Acquired on the Phoenix ICON. 1240 x 1240 pixels. Wide-field fundus photograph from neonatal ROP screening.
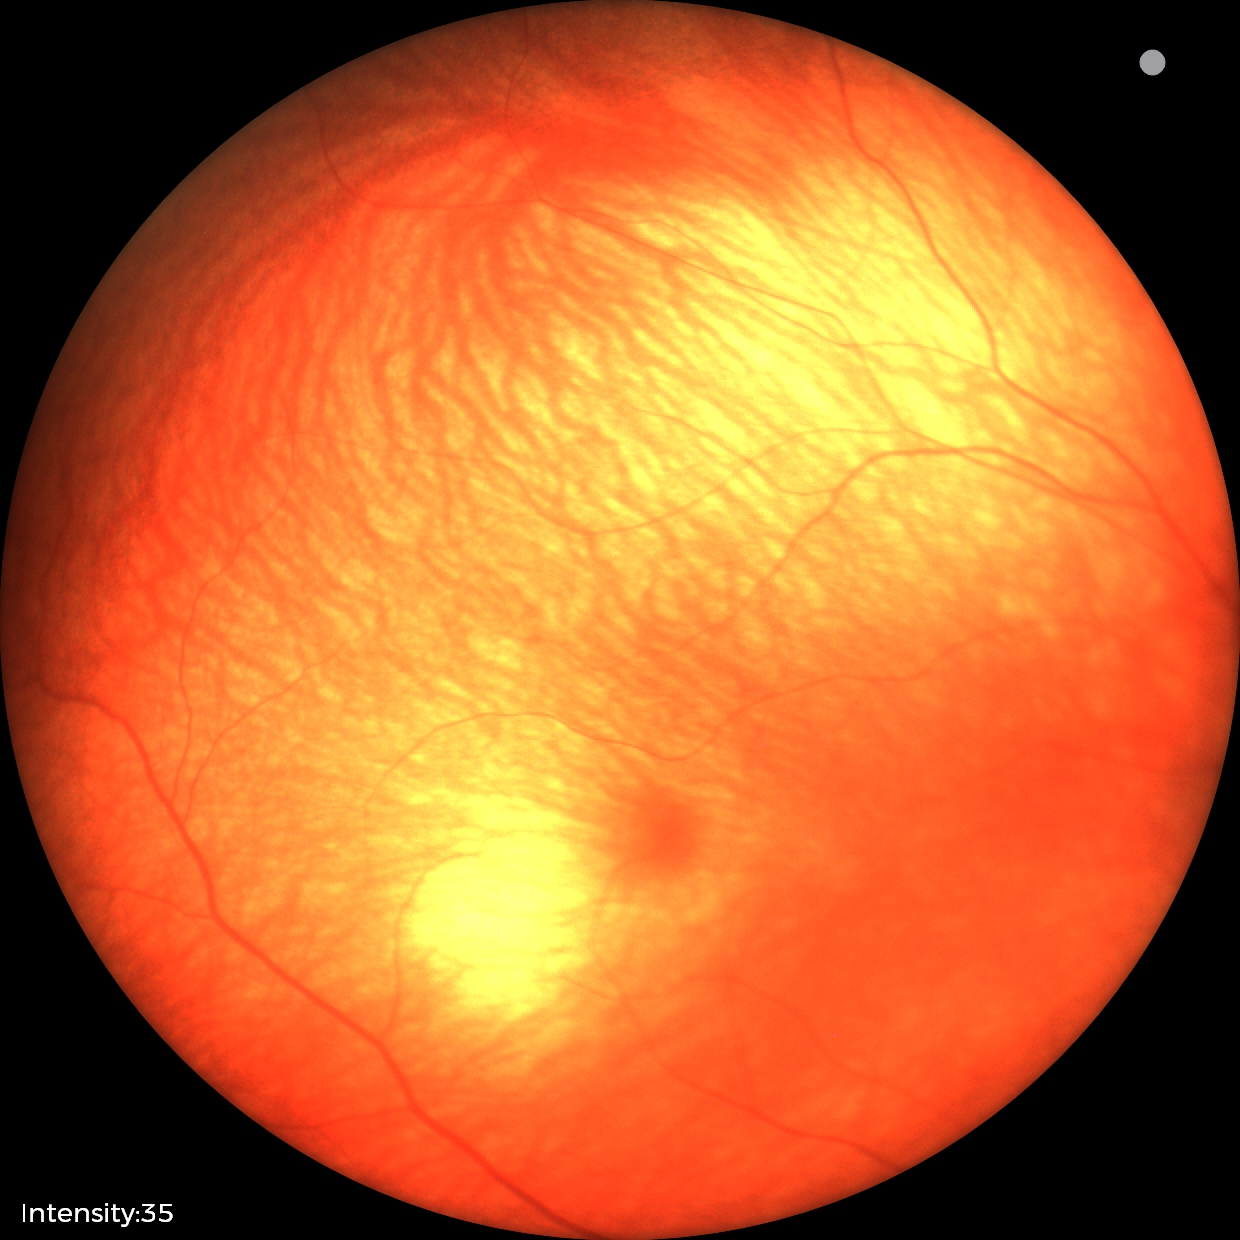

Examination with physiological retinal findings.